CFP, 45-degree field of view
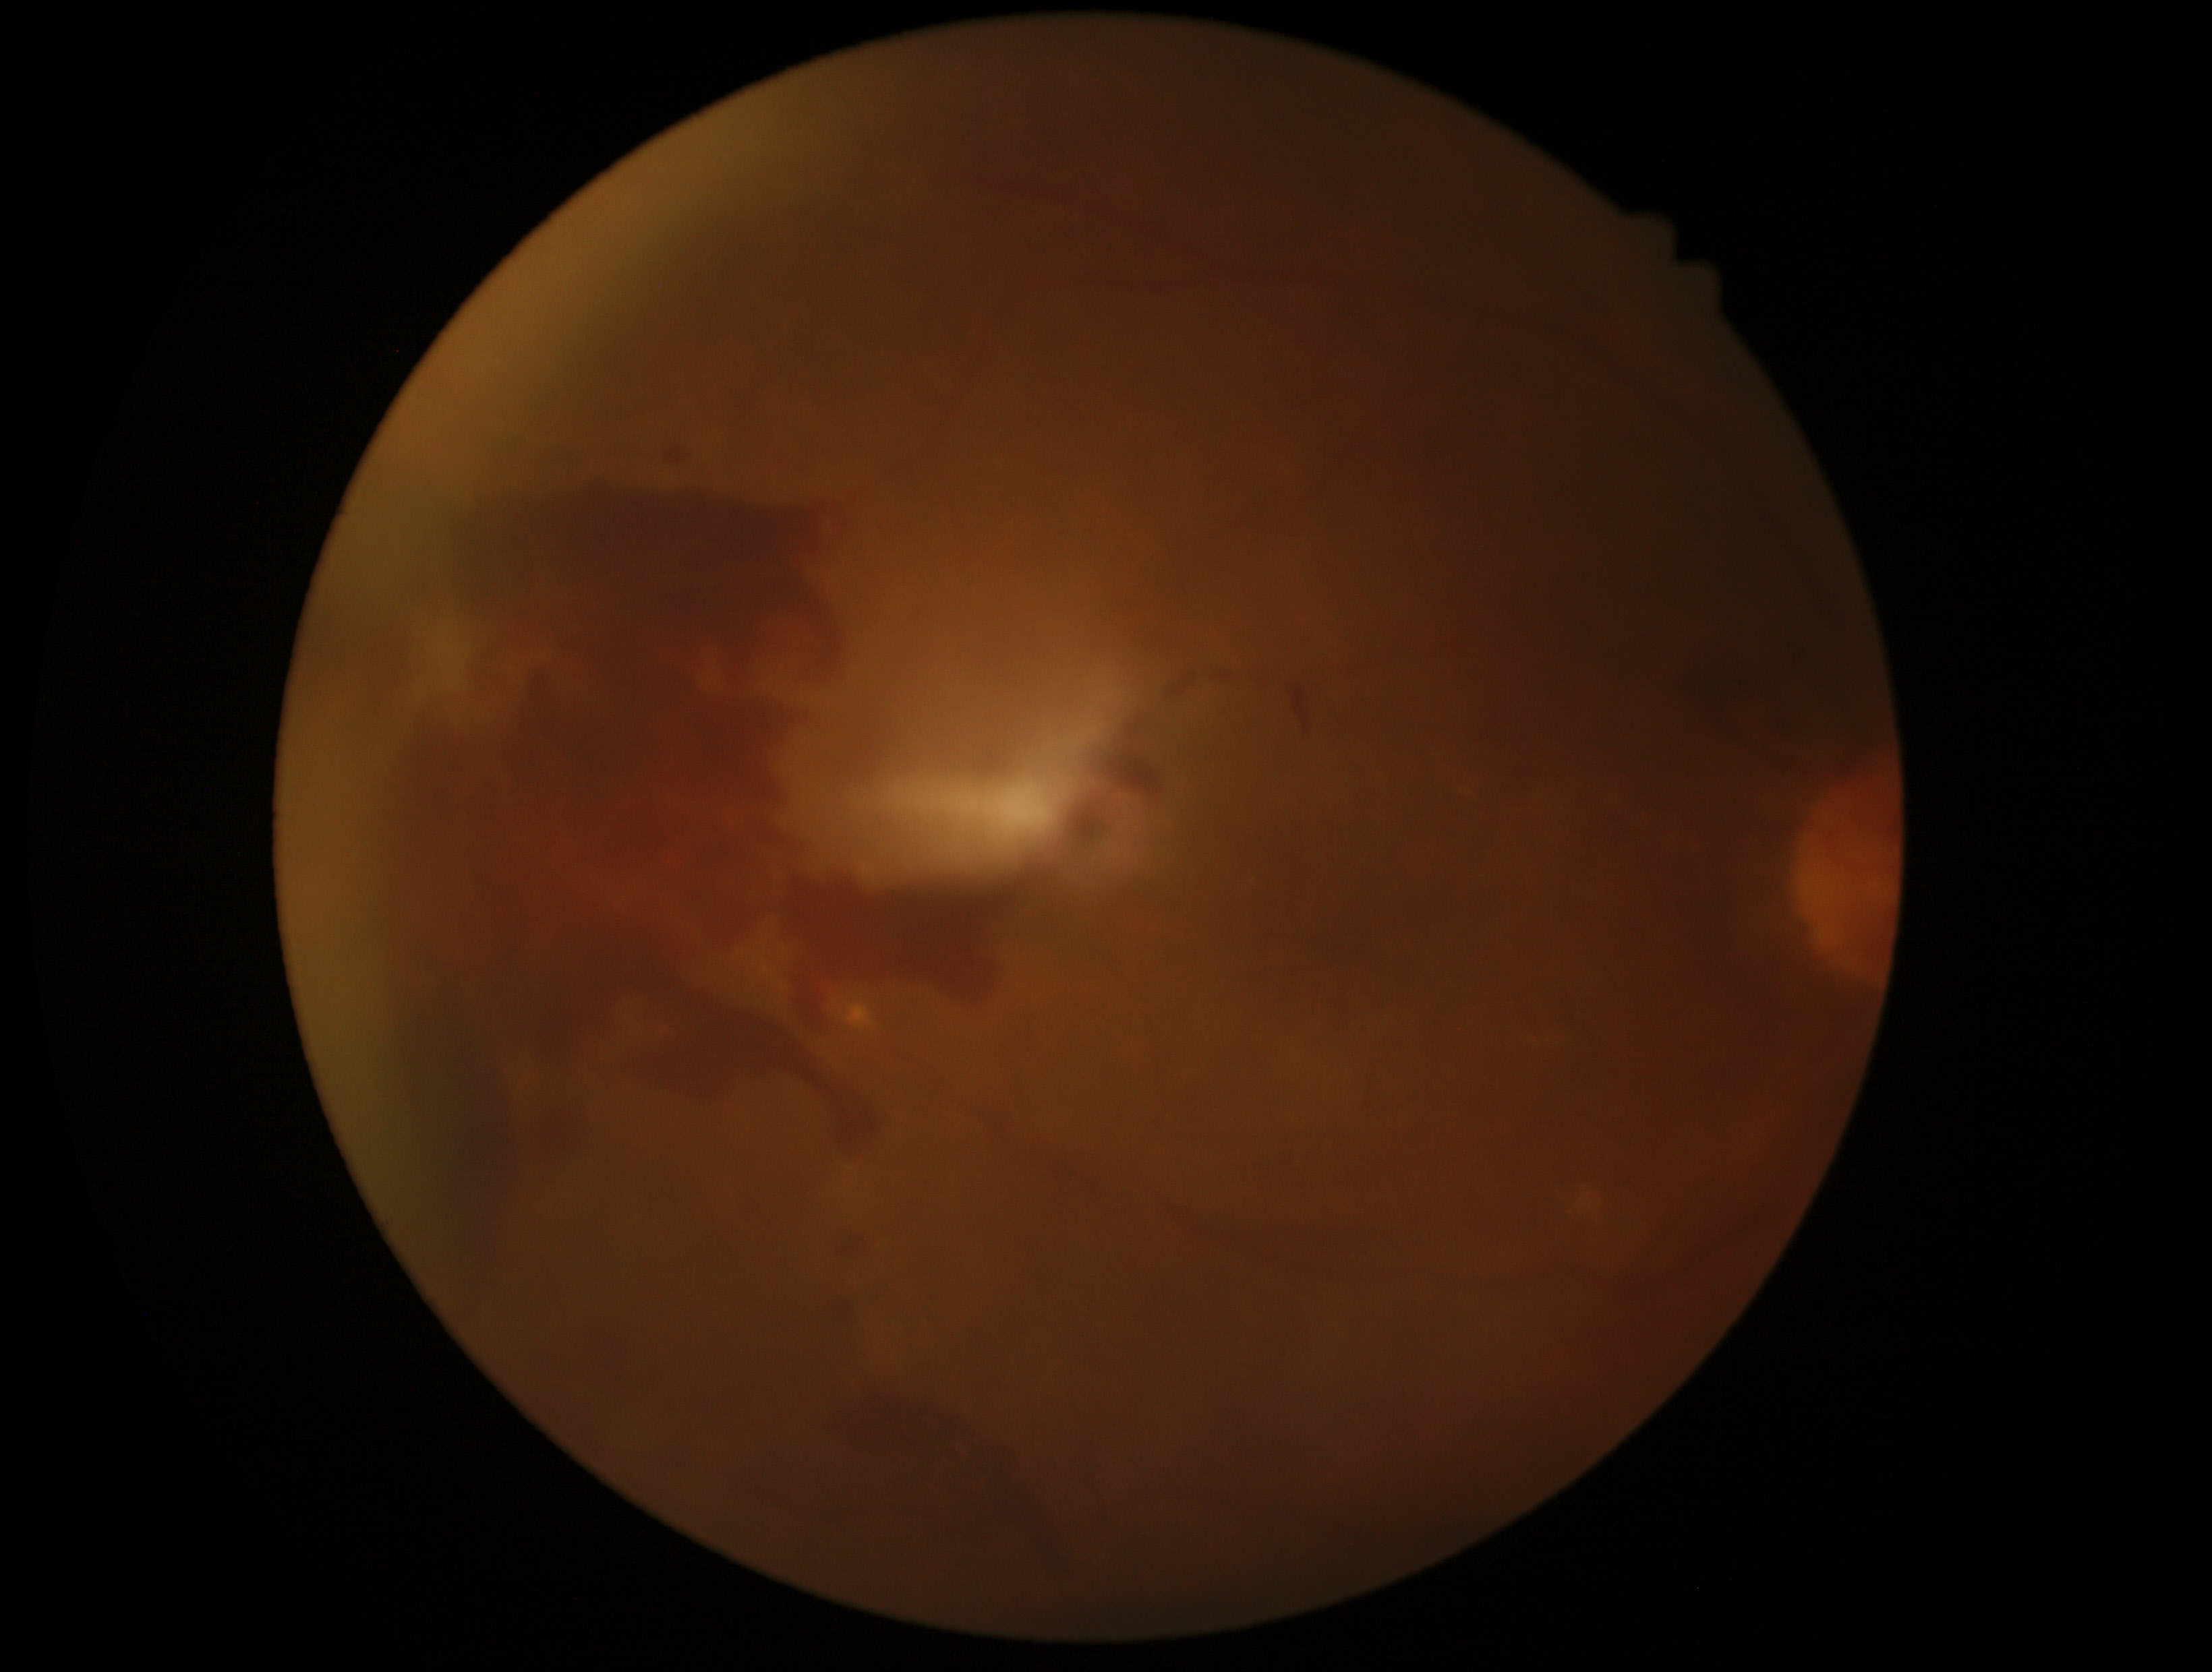

DR severity: proliferative diabetic retinopathy (grade 4).